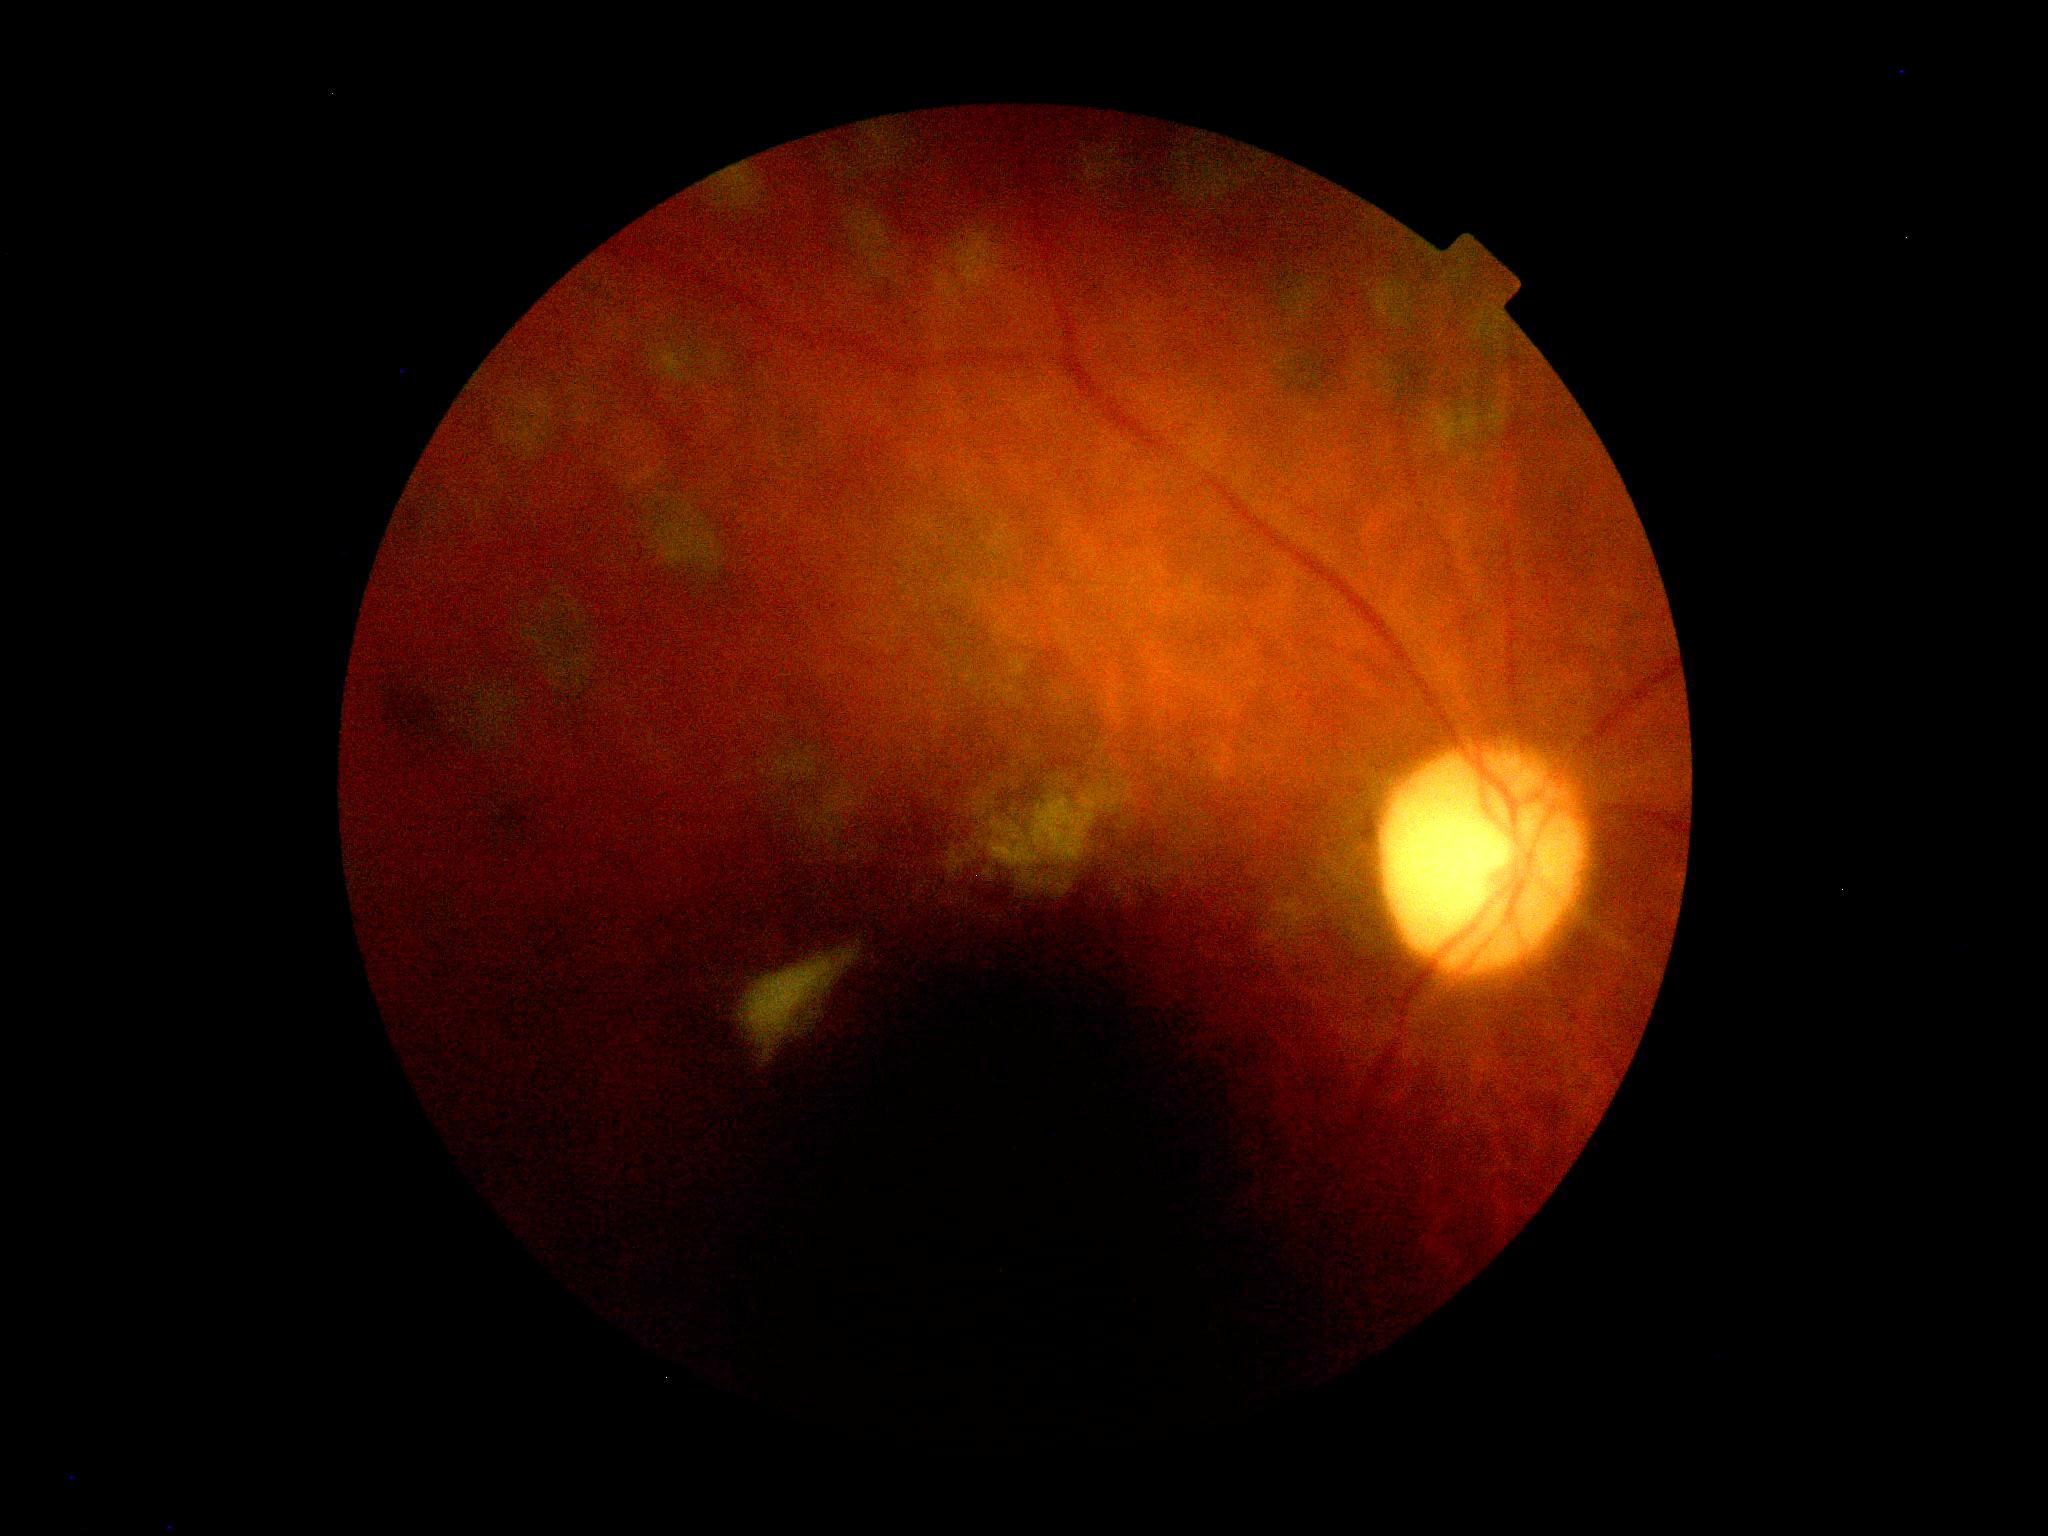 DR stage = ungradable due to poor image quality